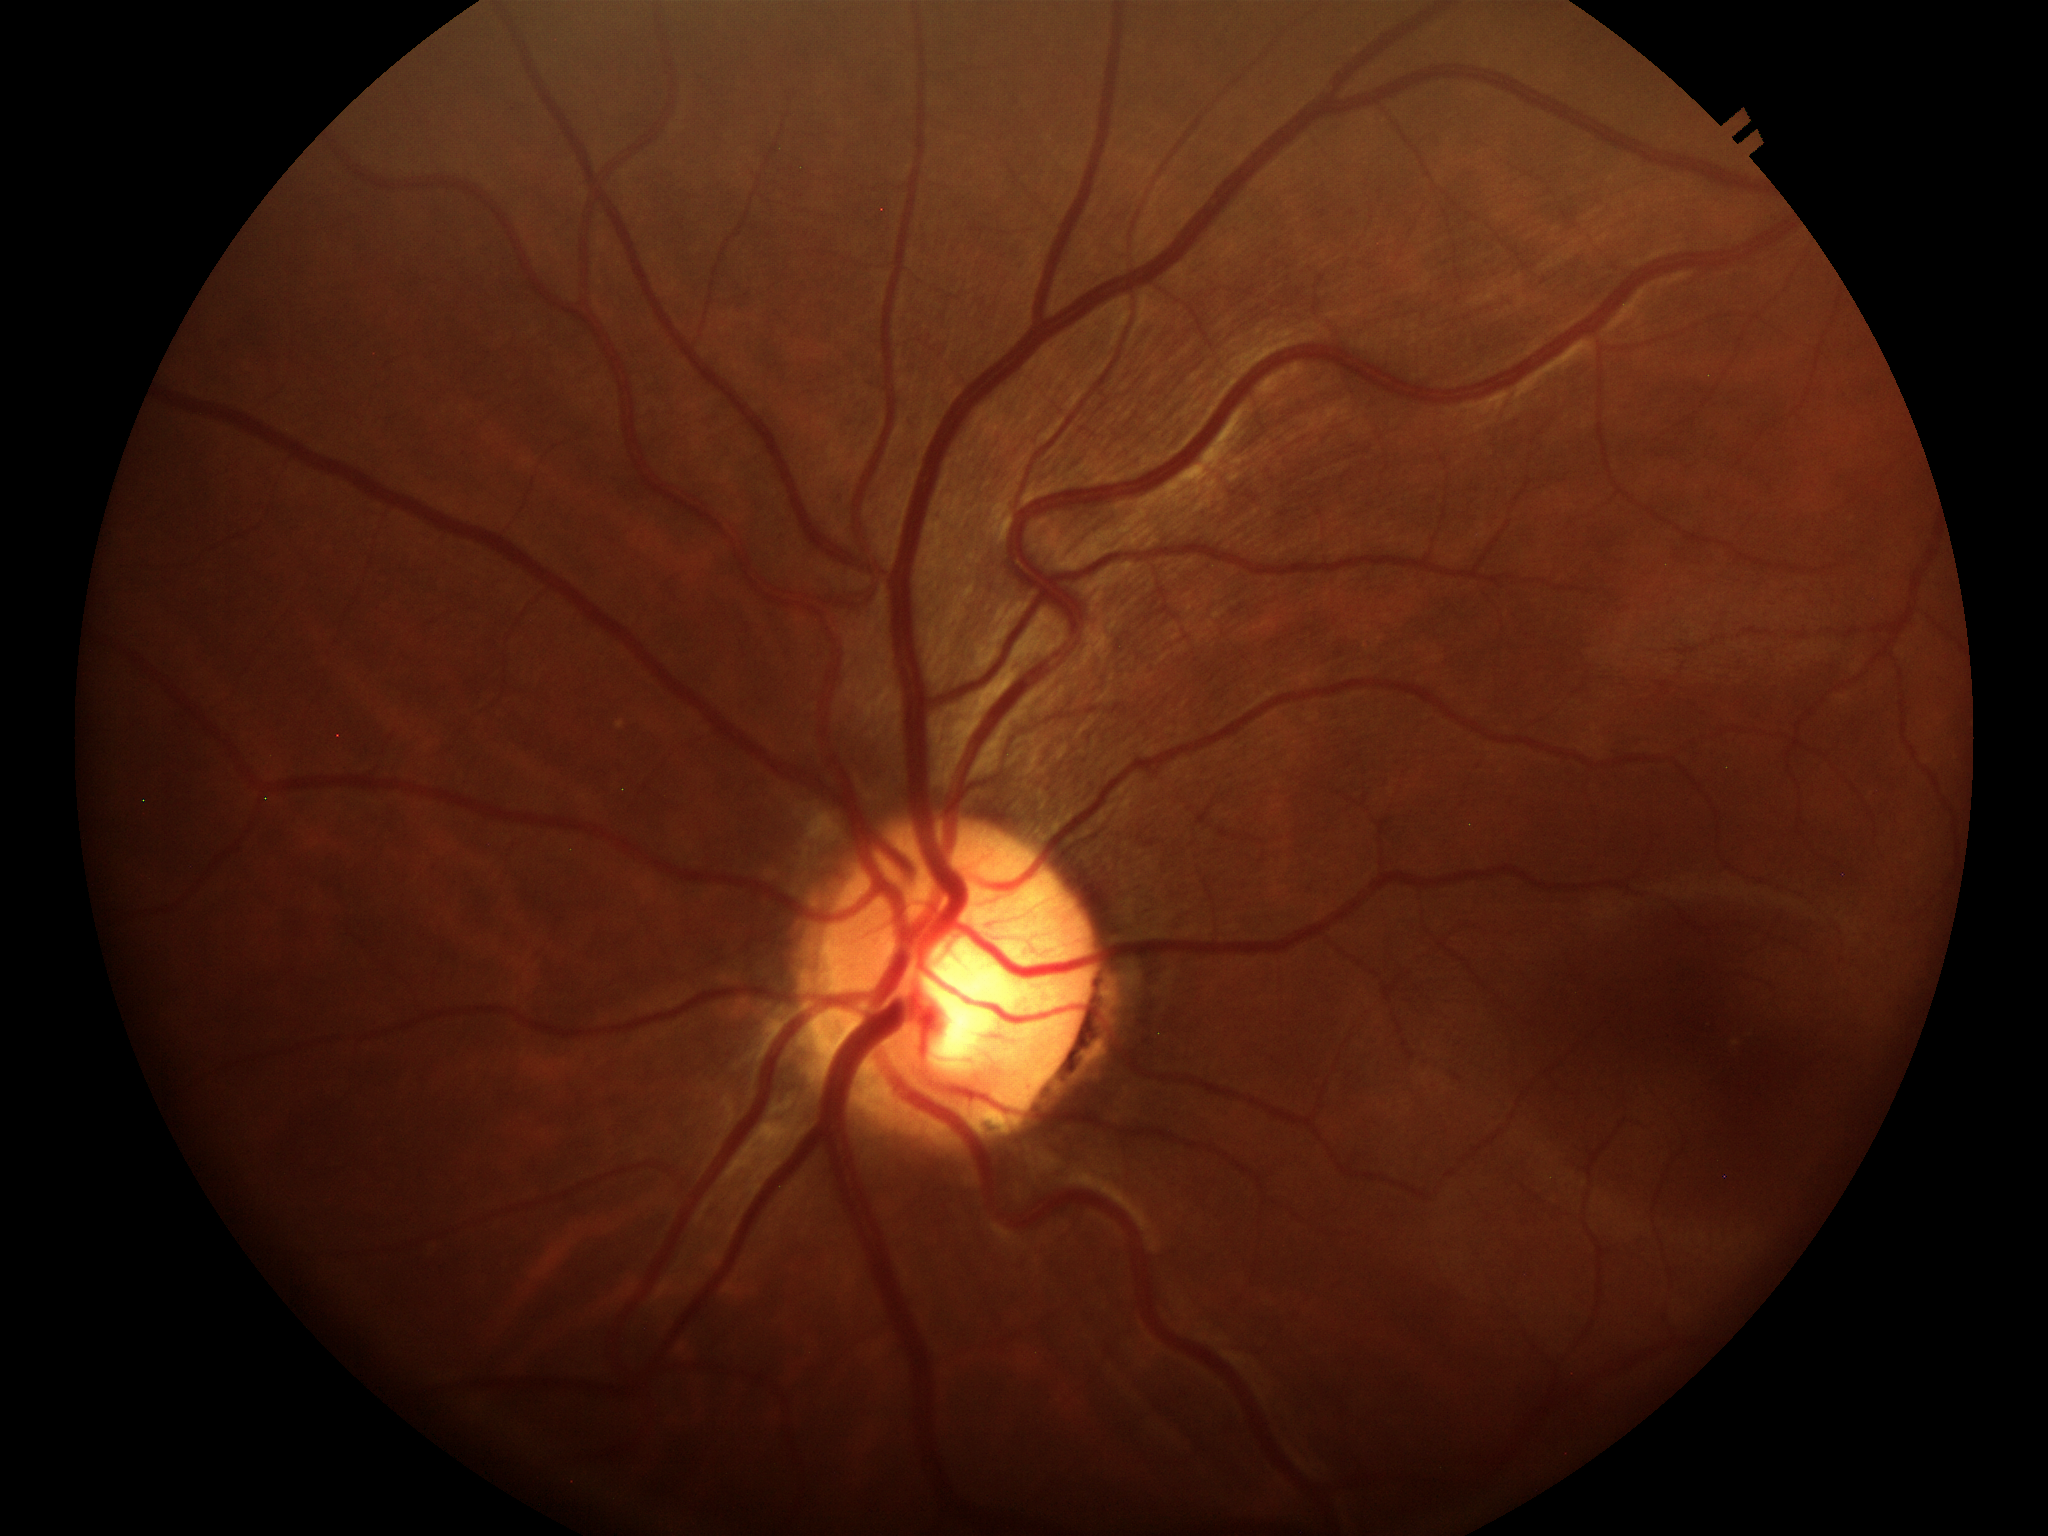 Glaucoma impression: no suspicious findings | VCDR: 0.56.